1932 x 1916 pixels, 45-degree field of view:
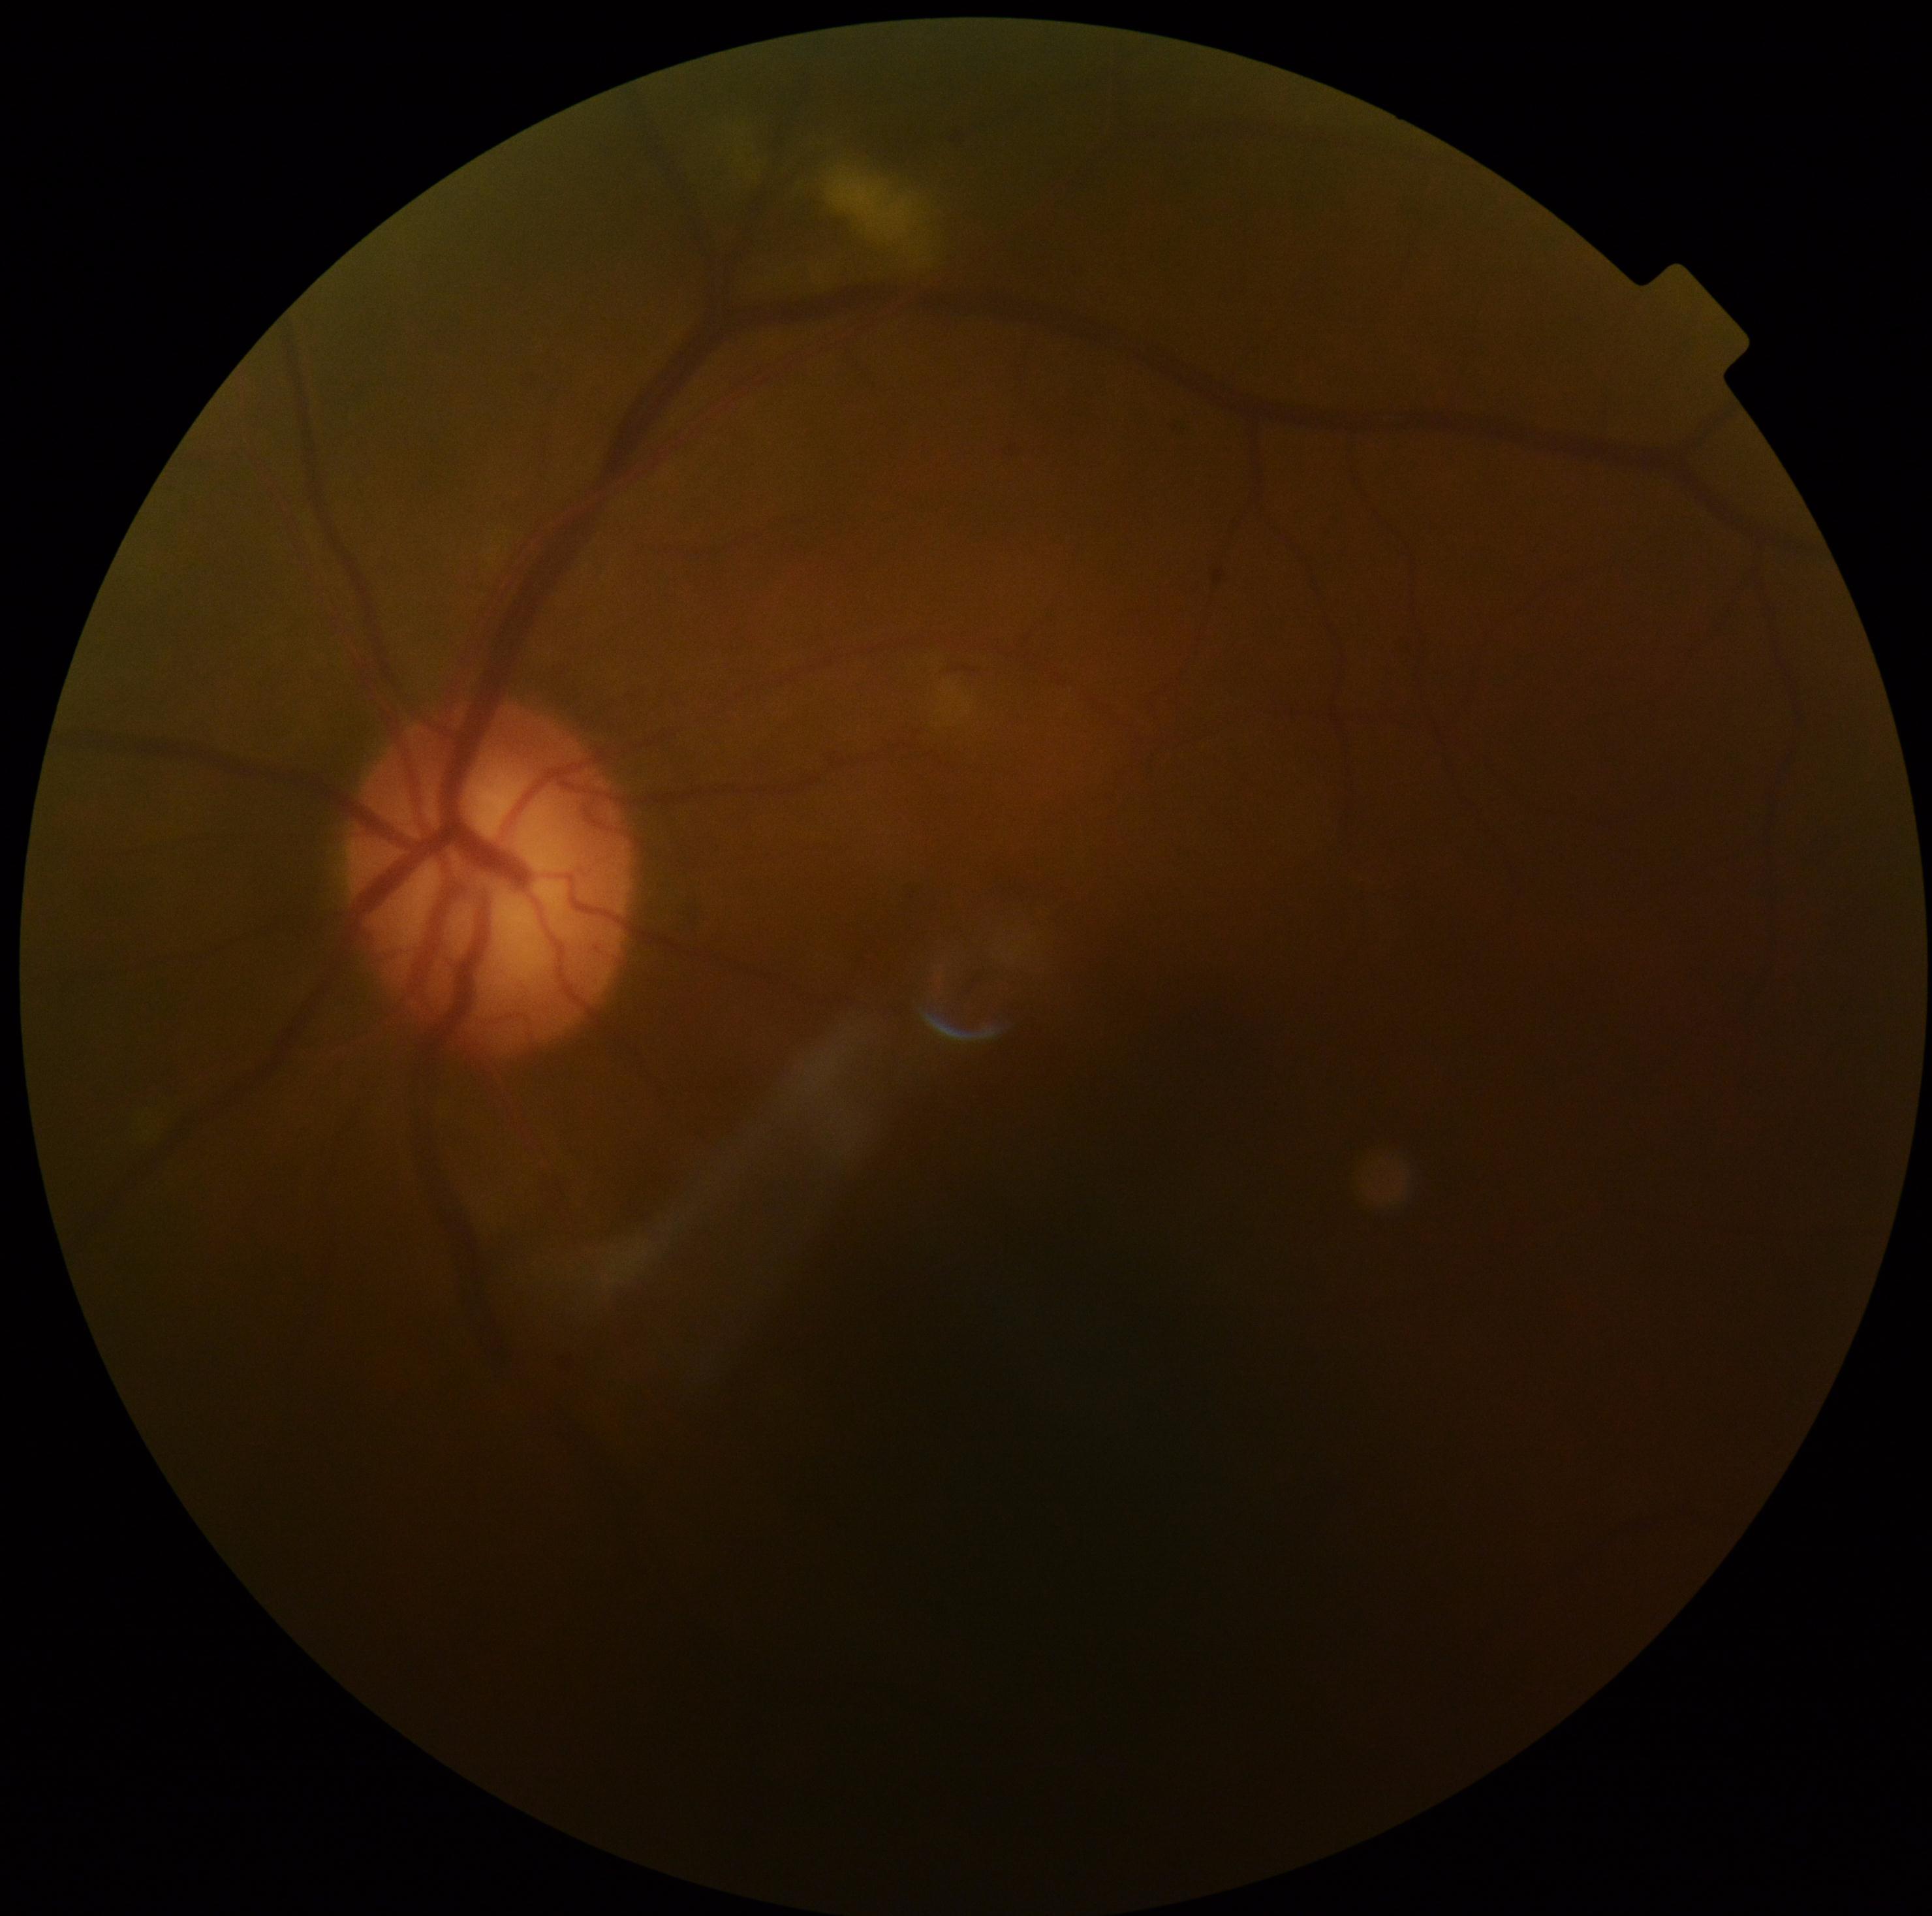
DR severity: moderate non-proliferative diabetic retinopathy (grade 2).